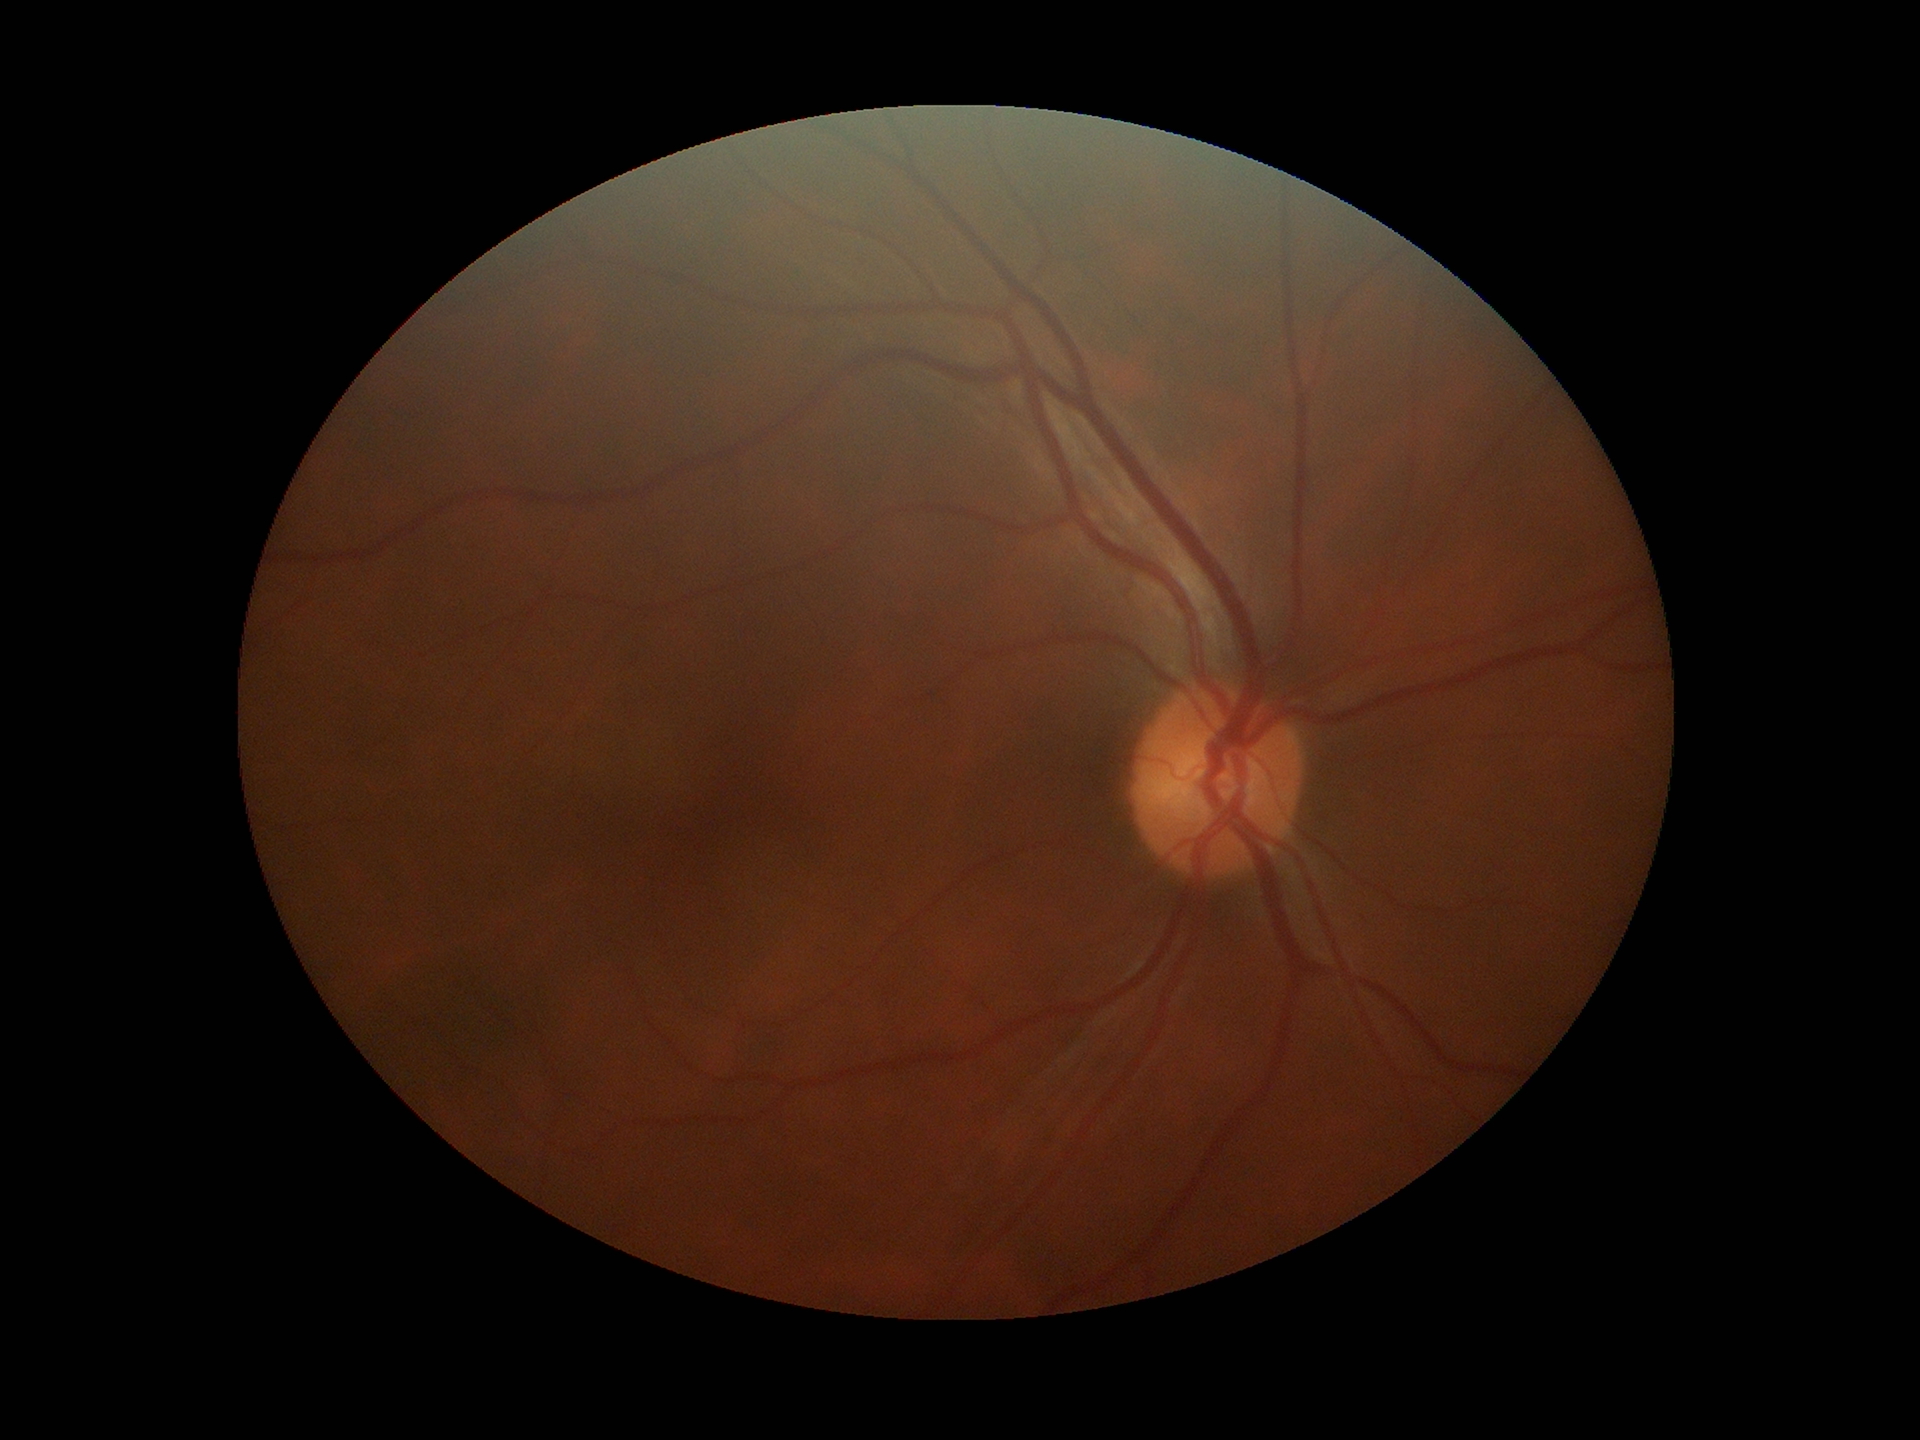

Glaucoma decision = no suspicious findings; vertical cup-to-disc ratio = 0.47; horizontal cup-disc ratio = 0.46.